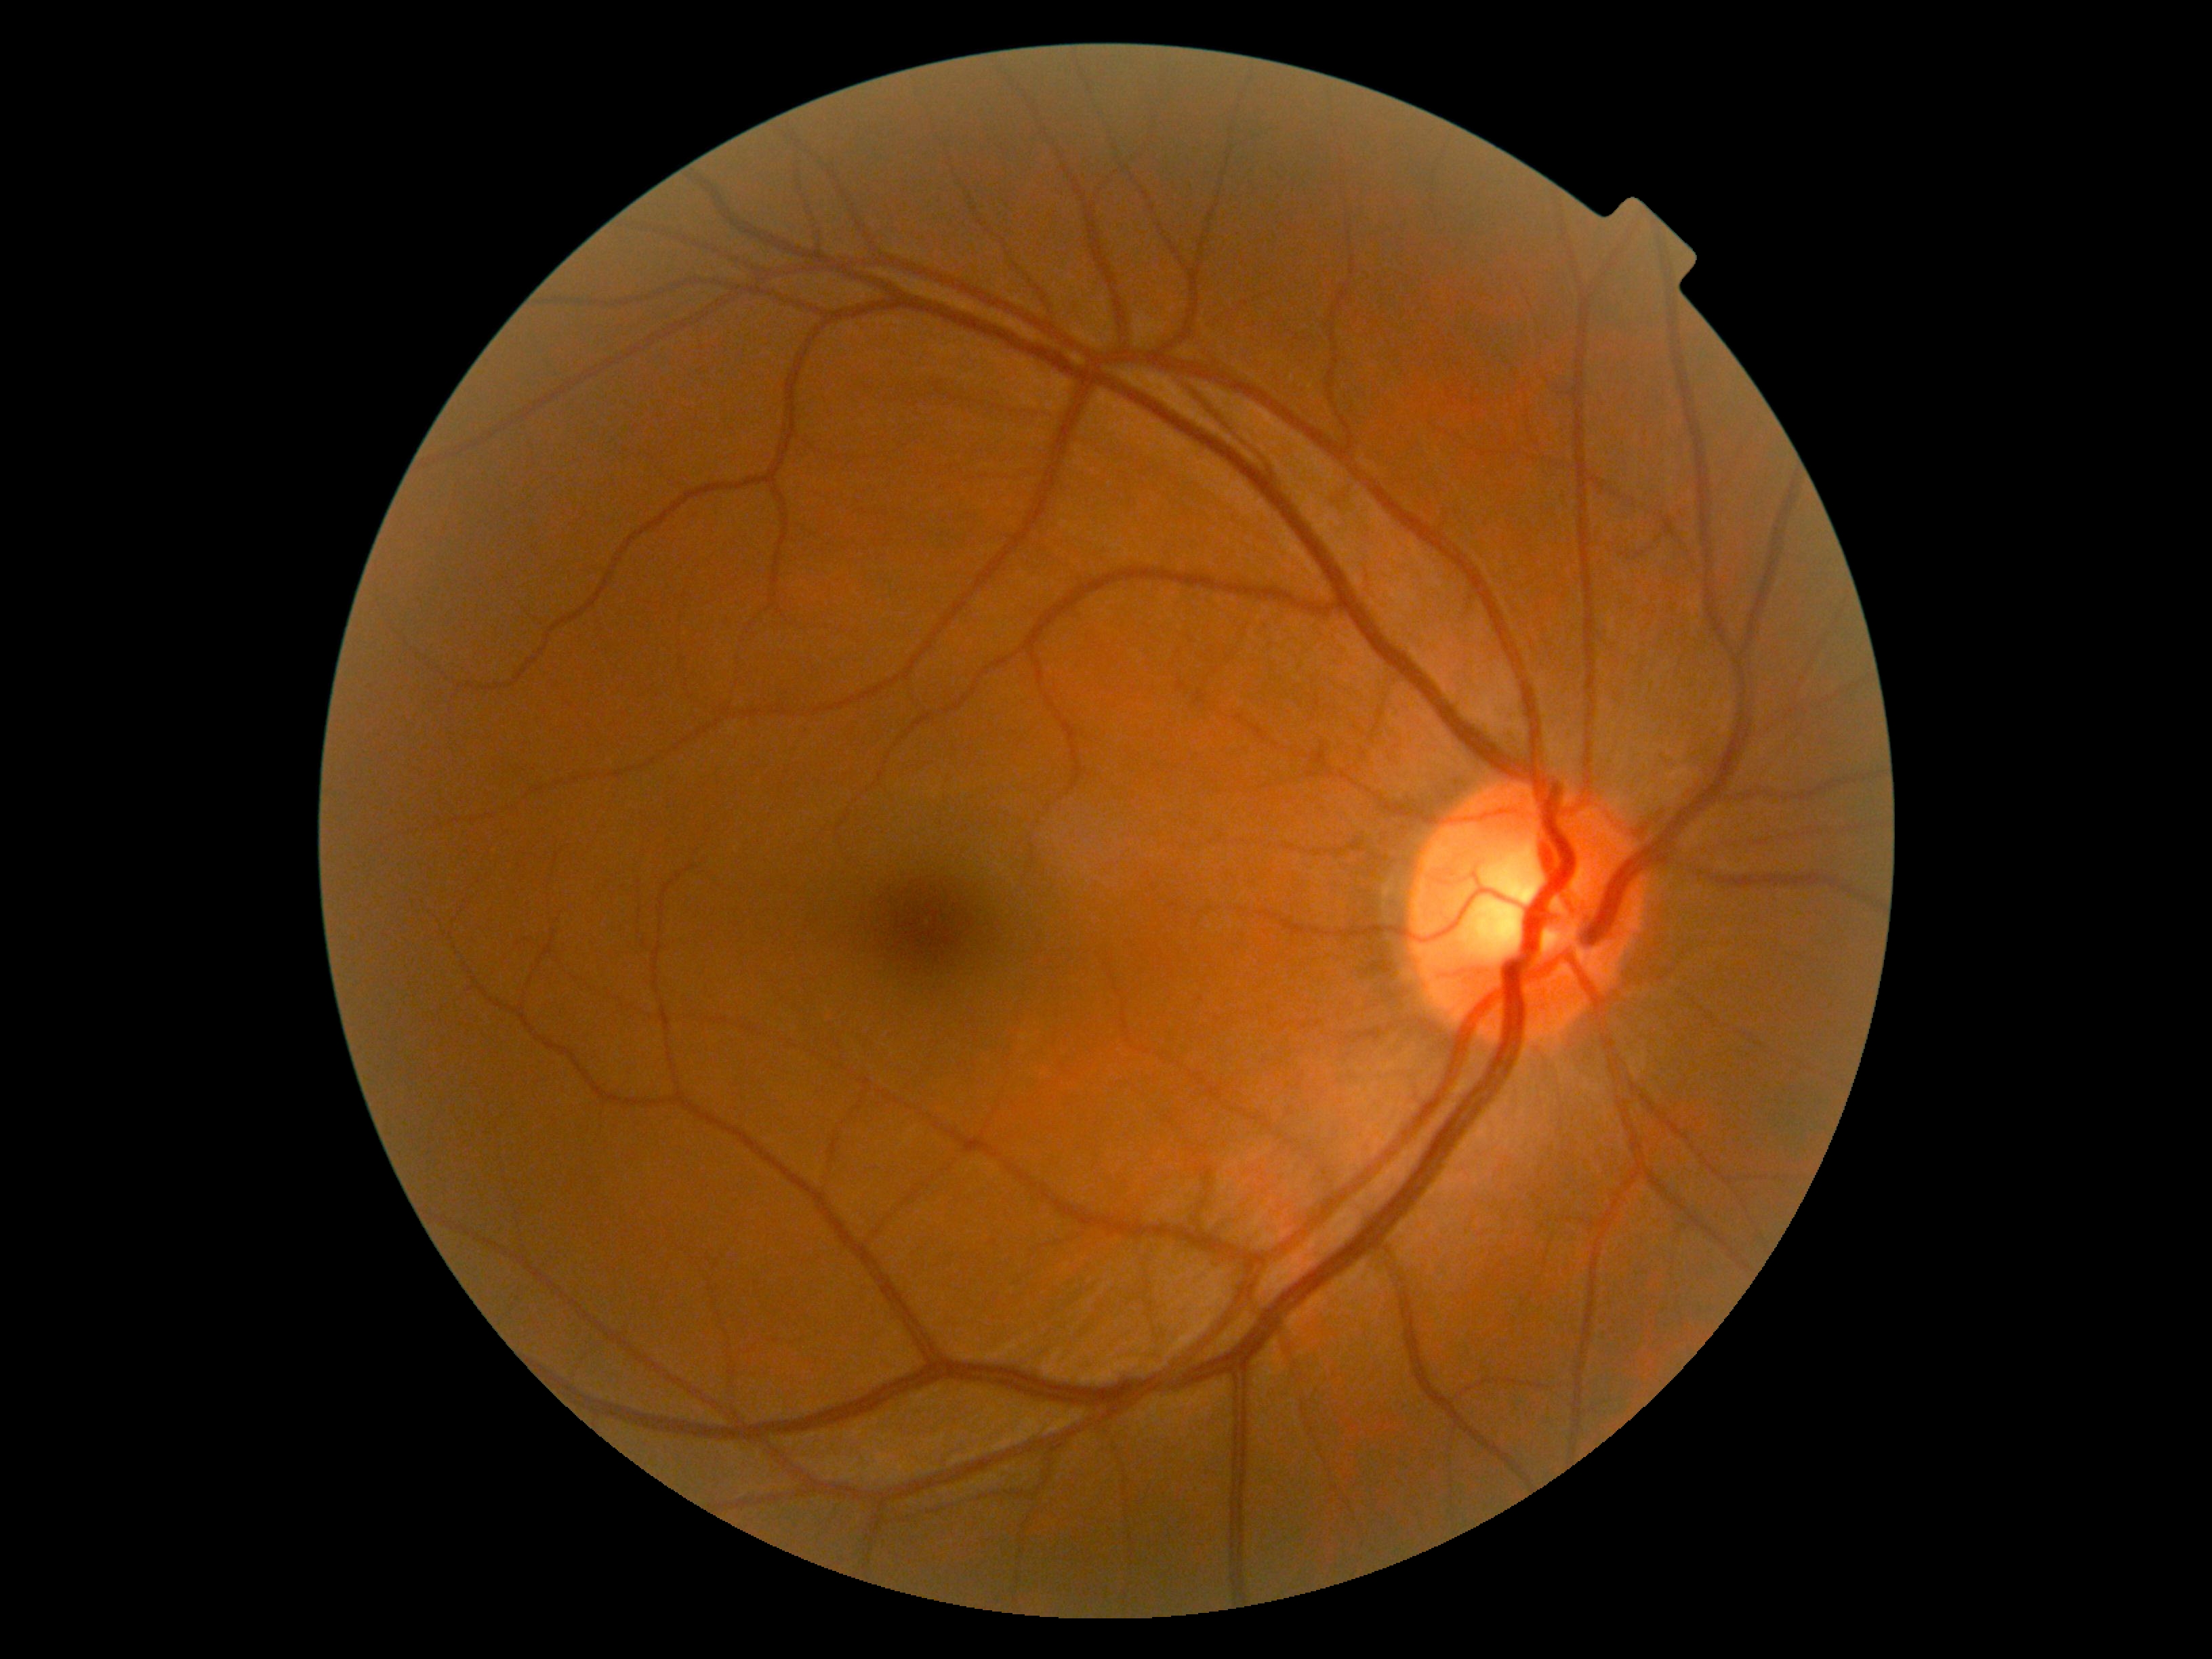
Diabetic retinopathy grade: no apparent retinopathy (0) — no visible signs of diabetic retinopathy.
No diabetic retinal disease findings.